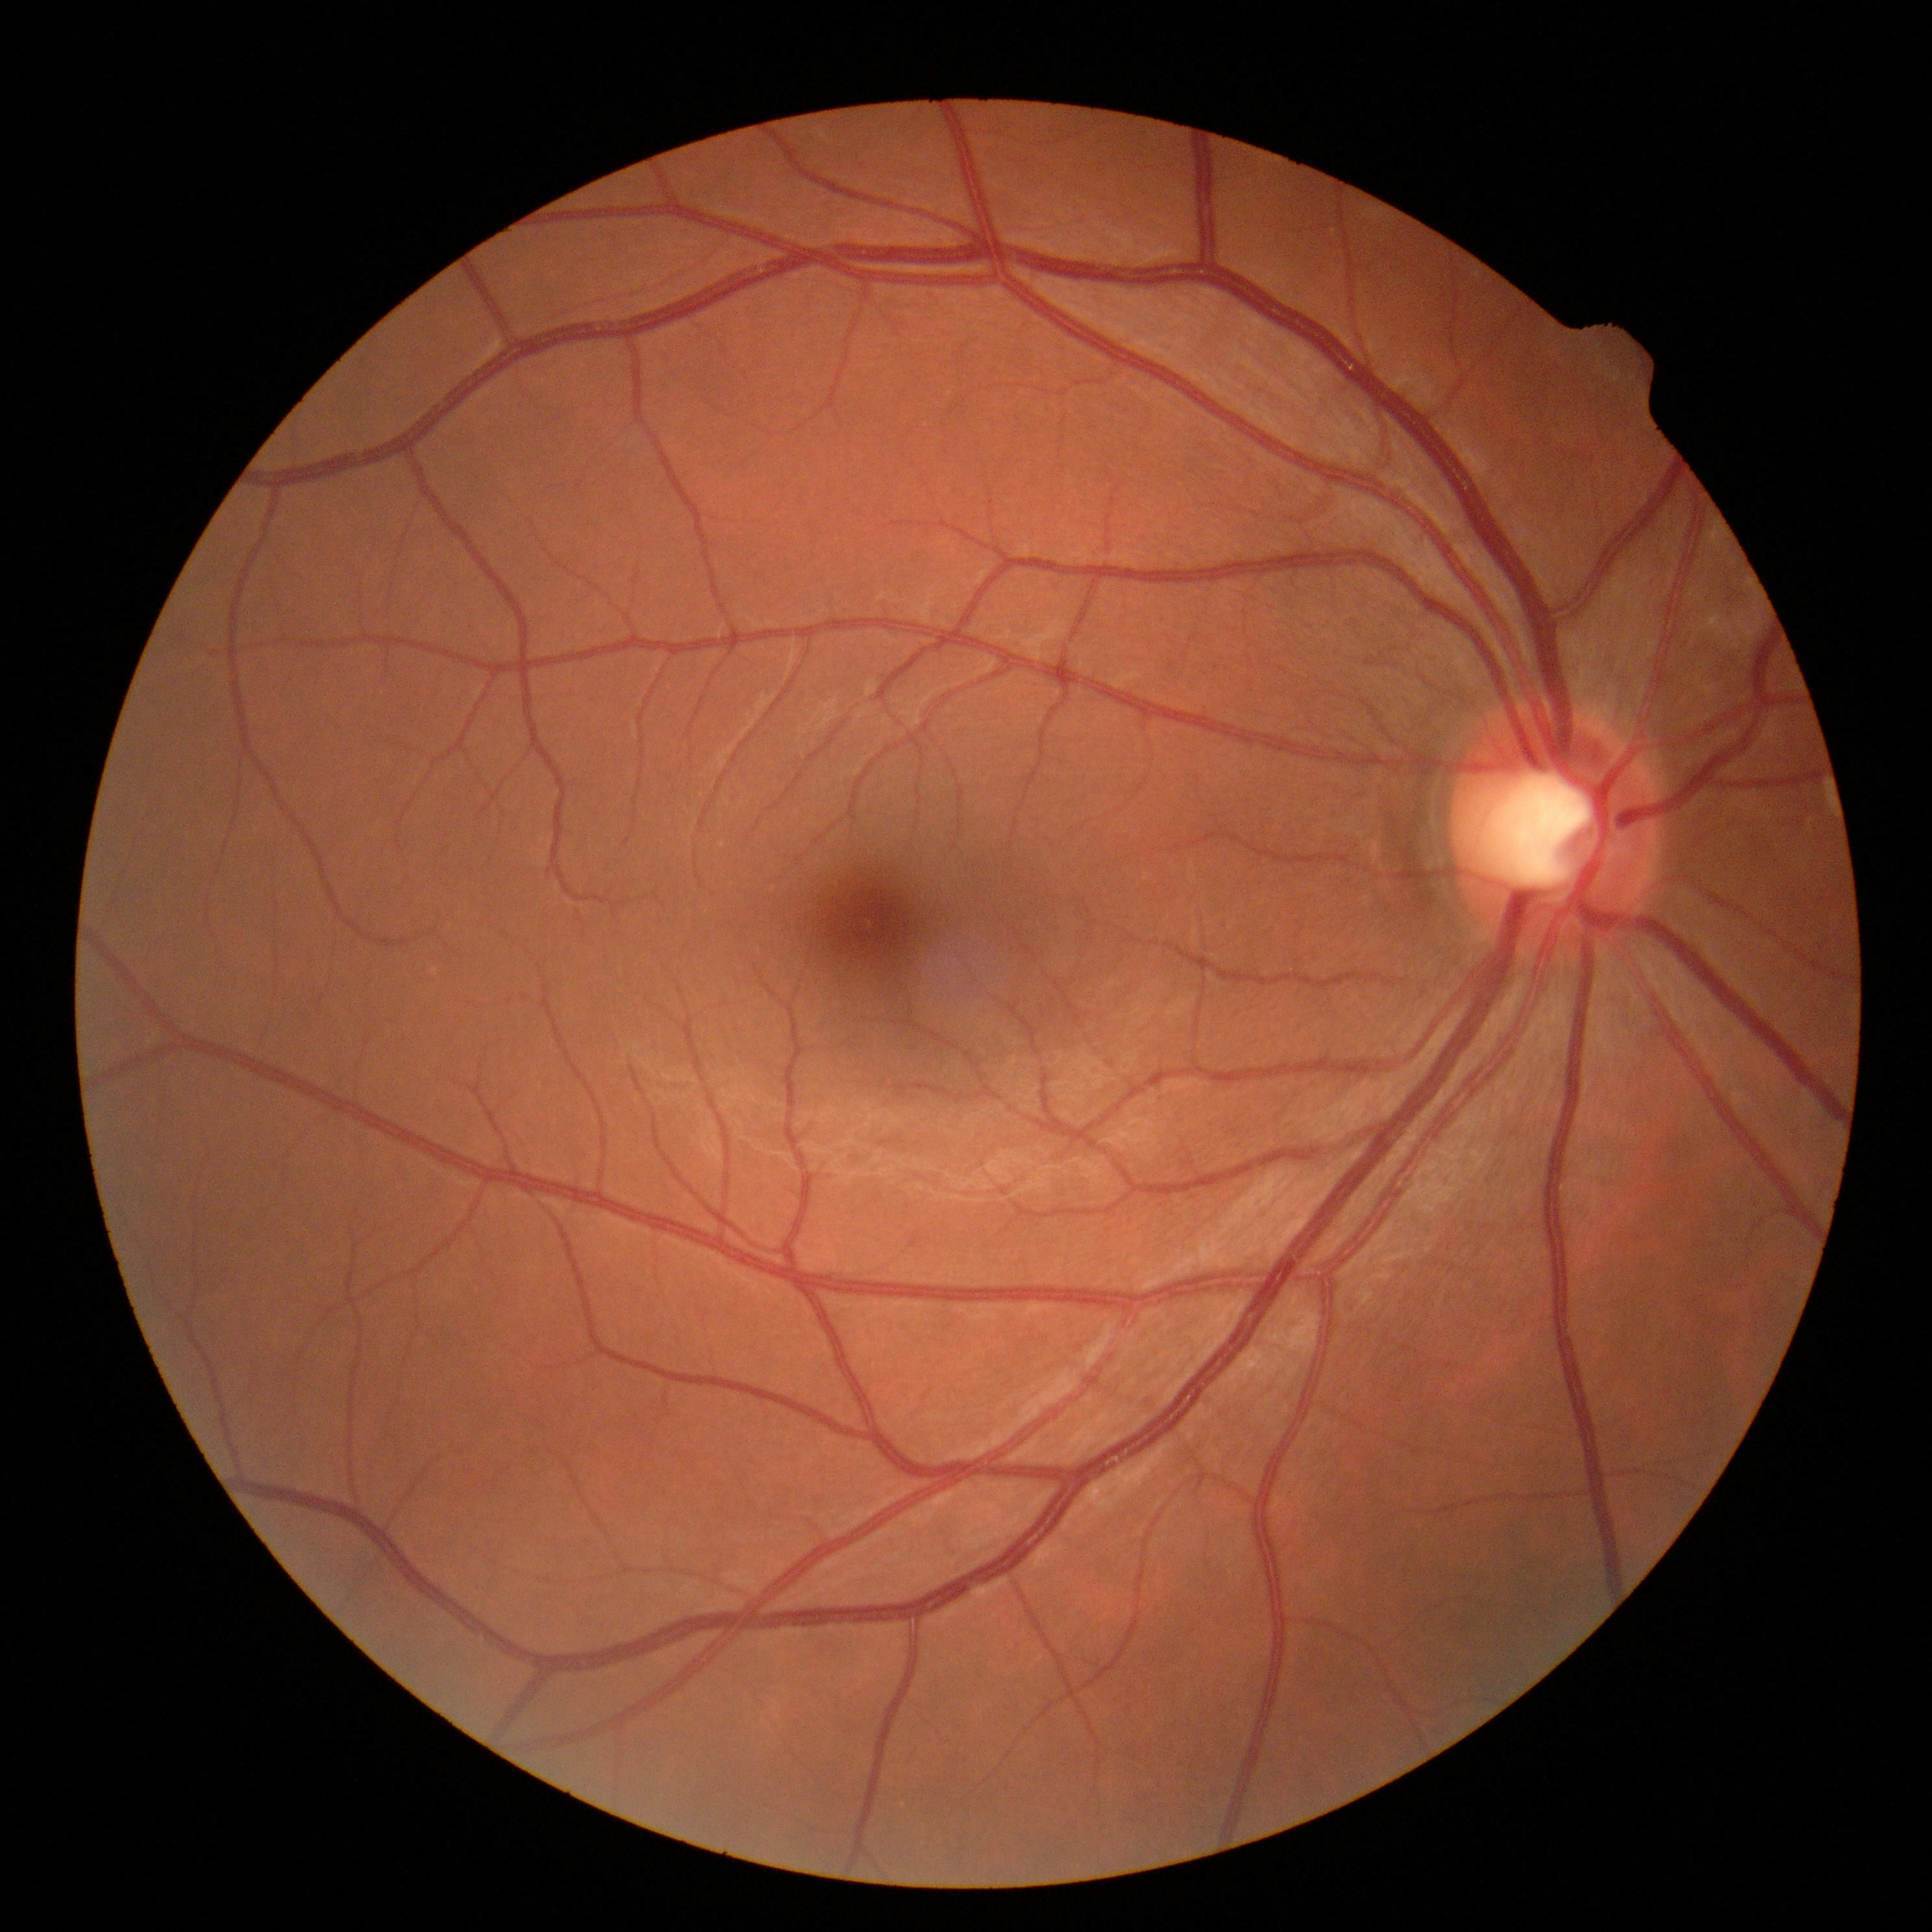

Diabetic retinopathy is grade 0.
No signs of diabetic retinopathy.